Diabetic retinopathy graded by the modified Davis classification; color fundus image — 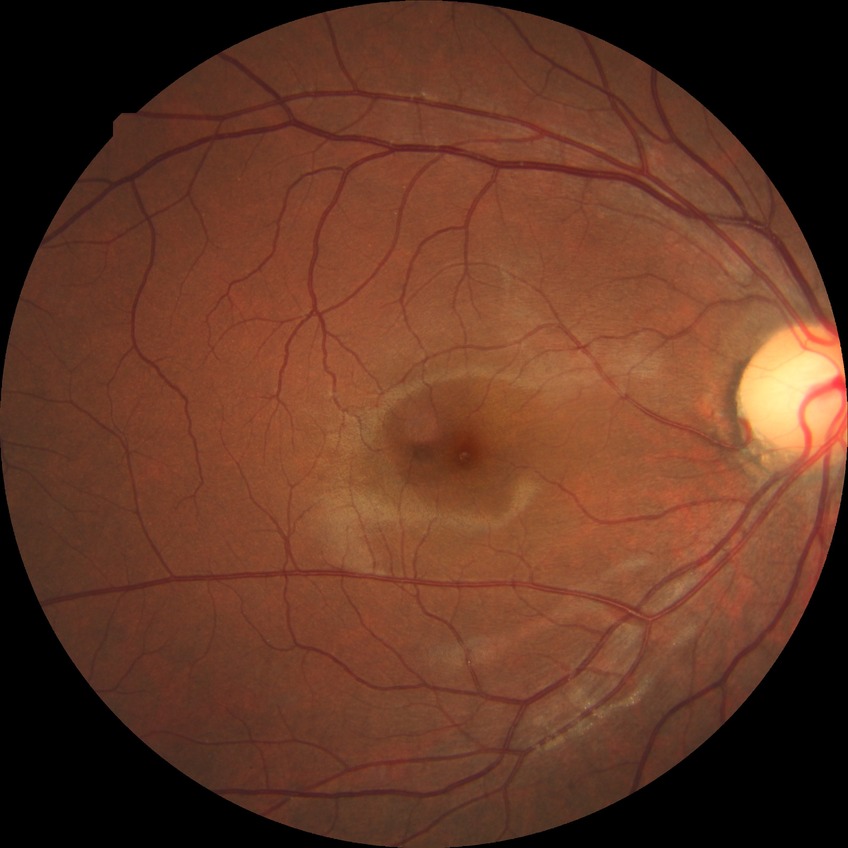

Diabetic retinopathy (DR): NDR (no diabetic retinopathy).